45° field of view:
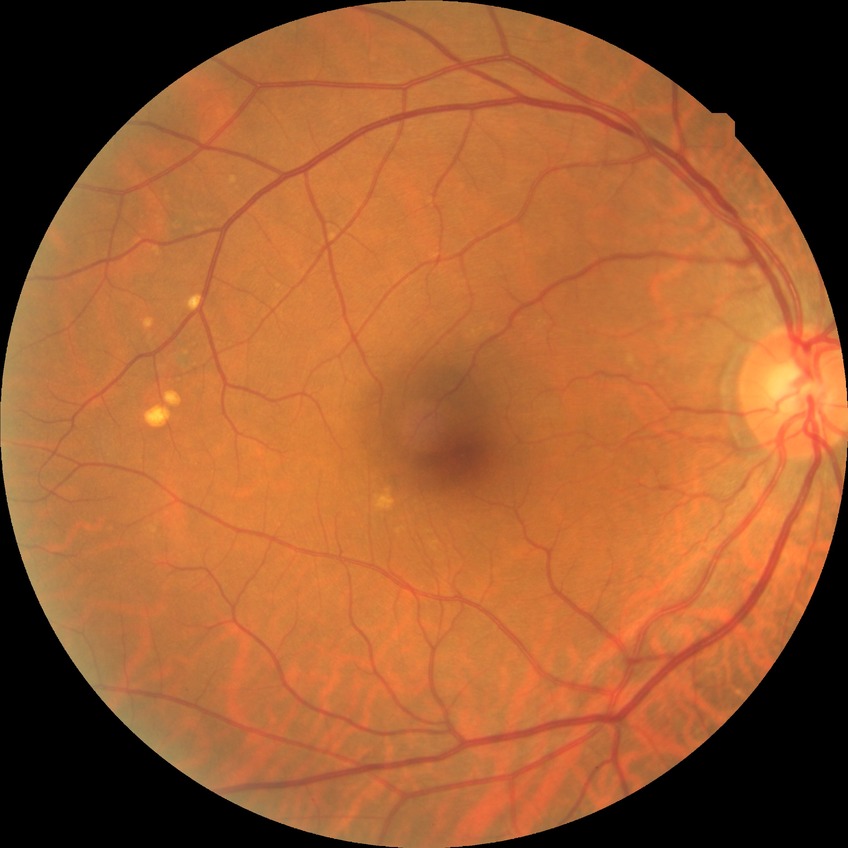 diabetic retinopathy grade: no diabetic retinopathy